Centered on the optic disc: 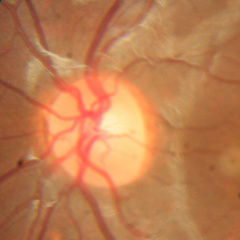
Q: What is the glaucoma diagnosis?
A: No glaucoma.